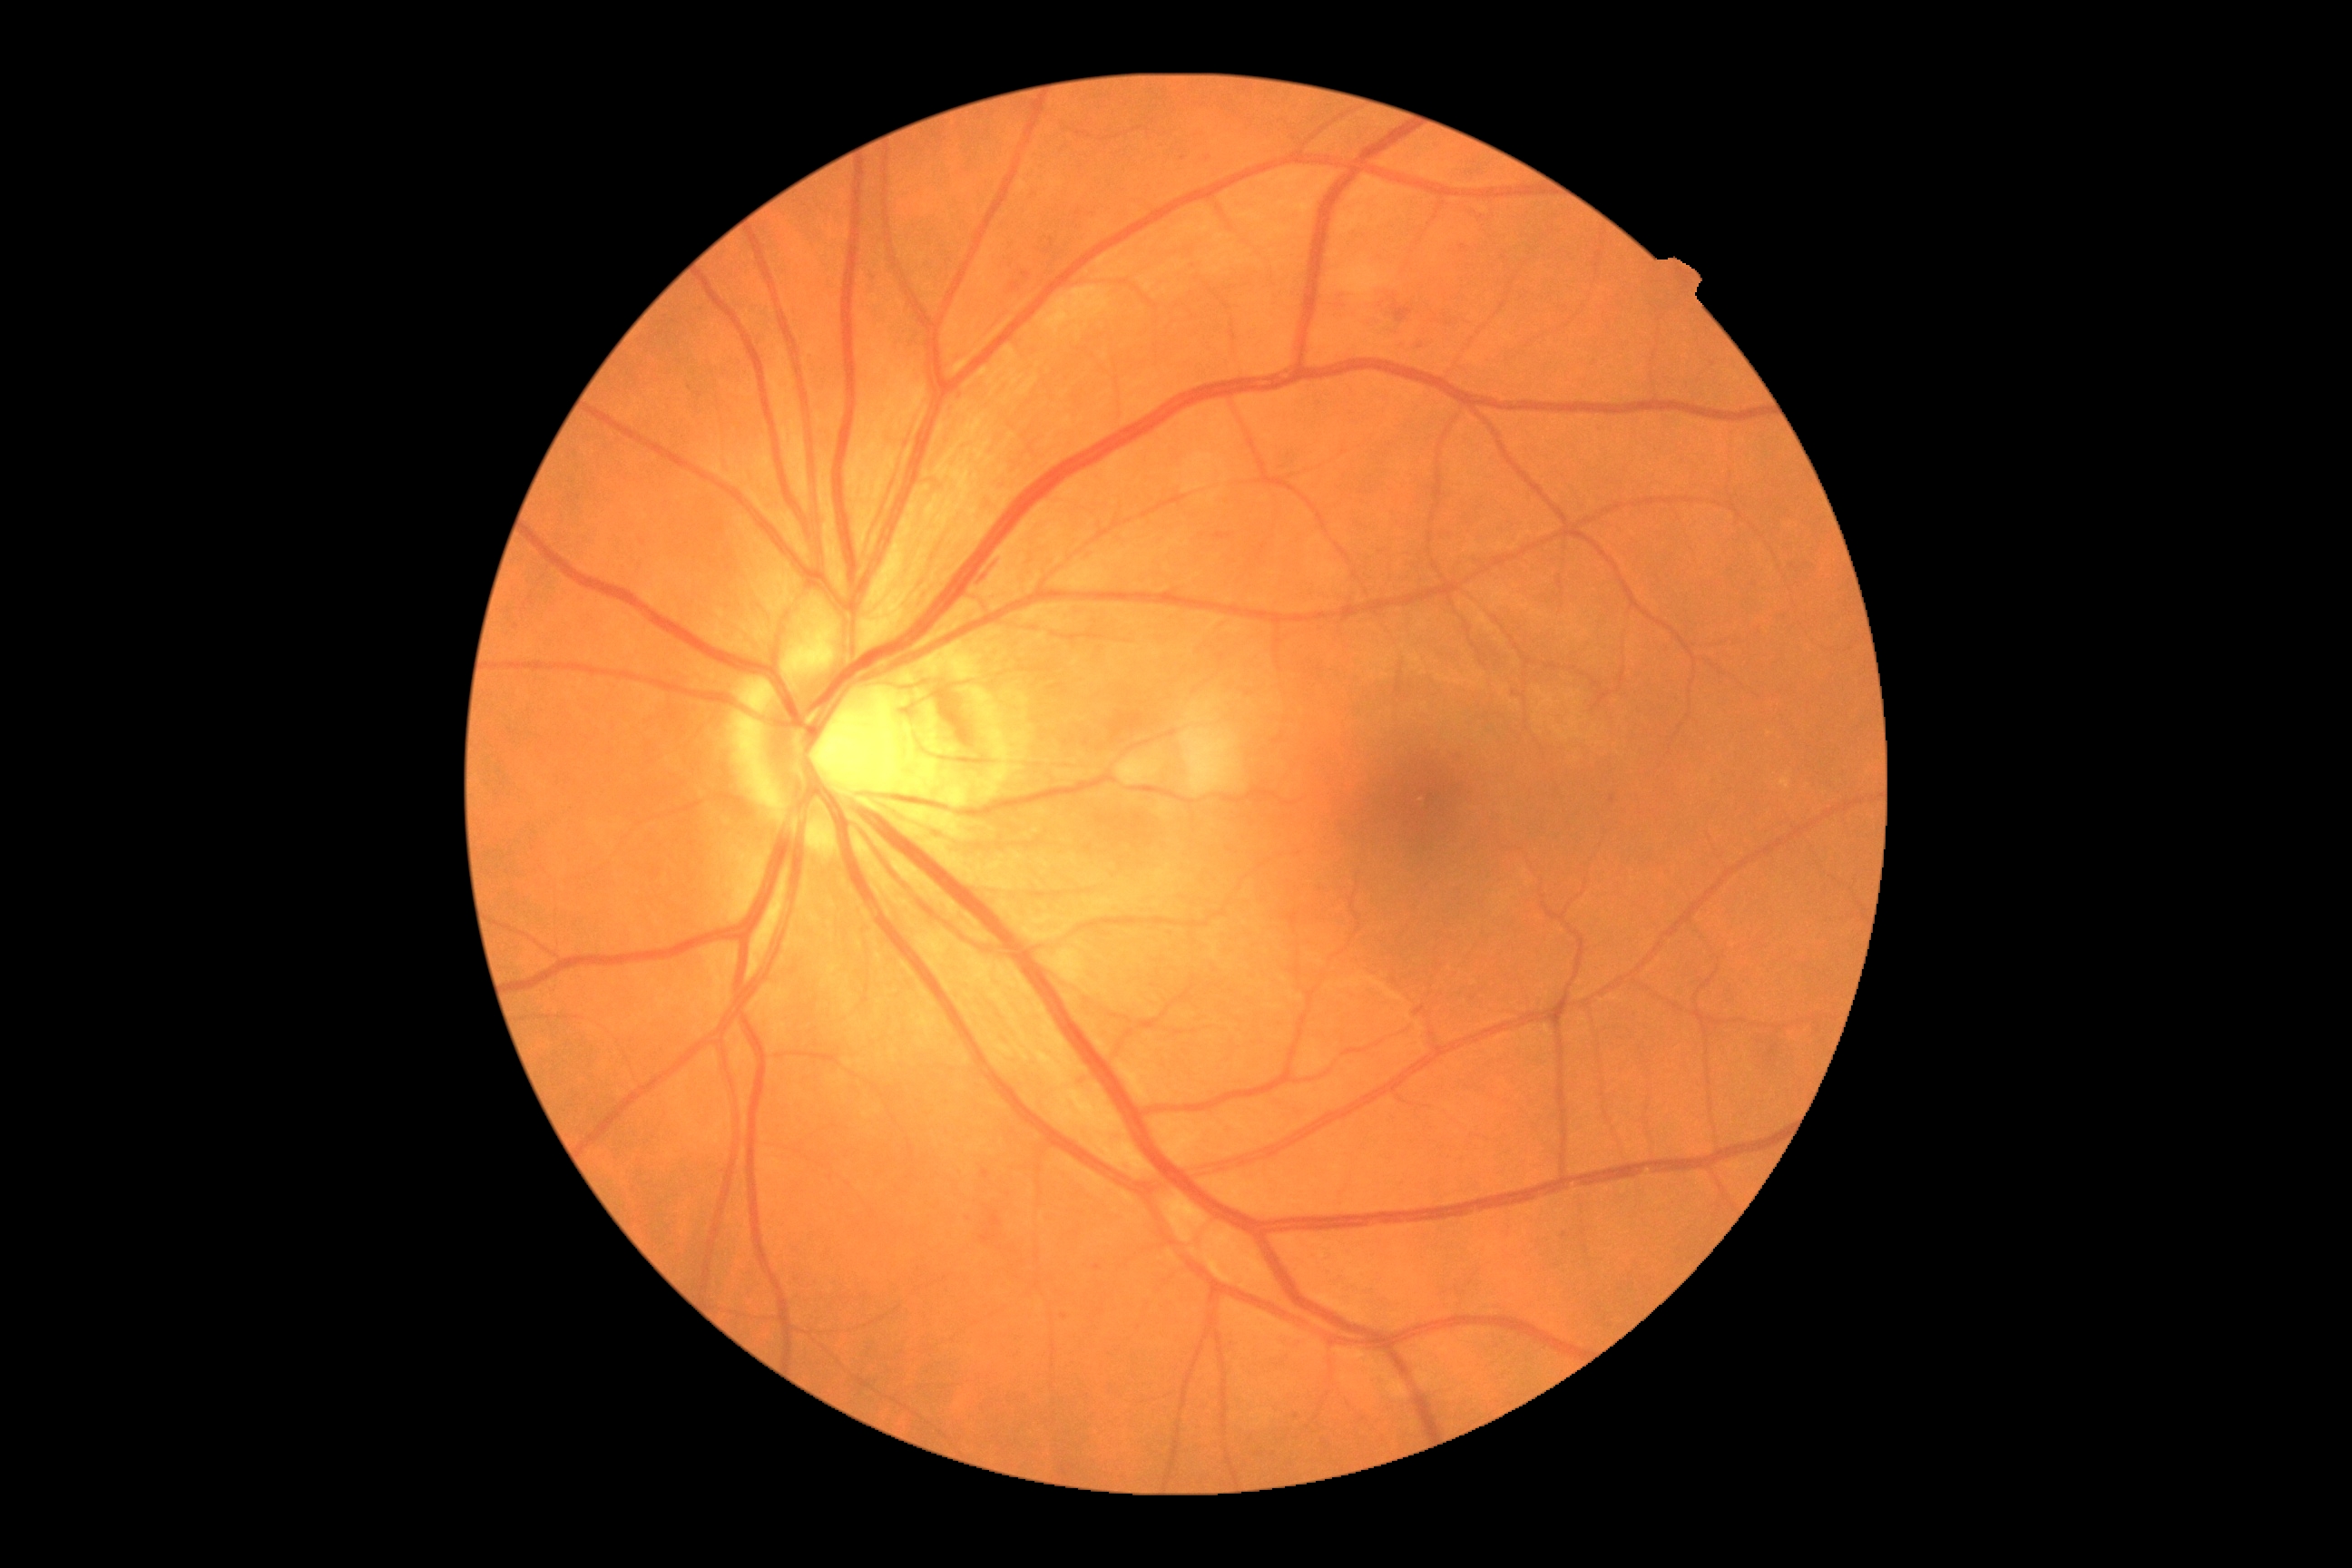 DR grade: 2. DR class: non-proliferative diabetic retinopathy.